Fundus photo:
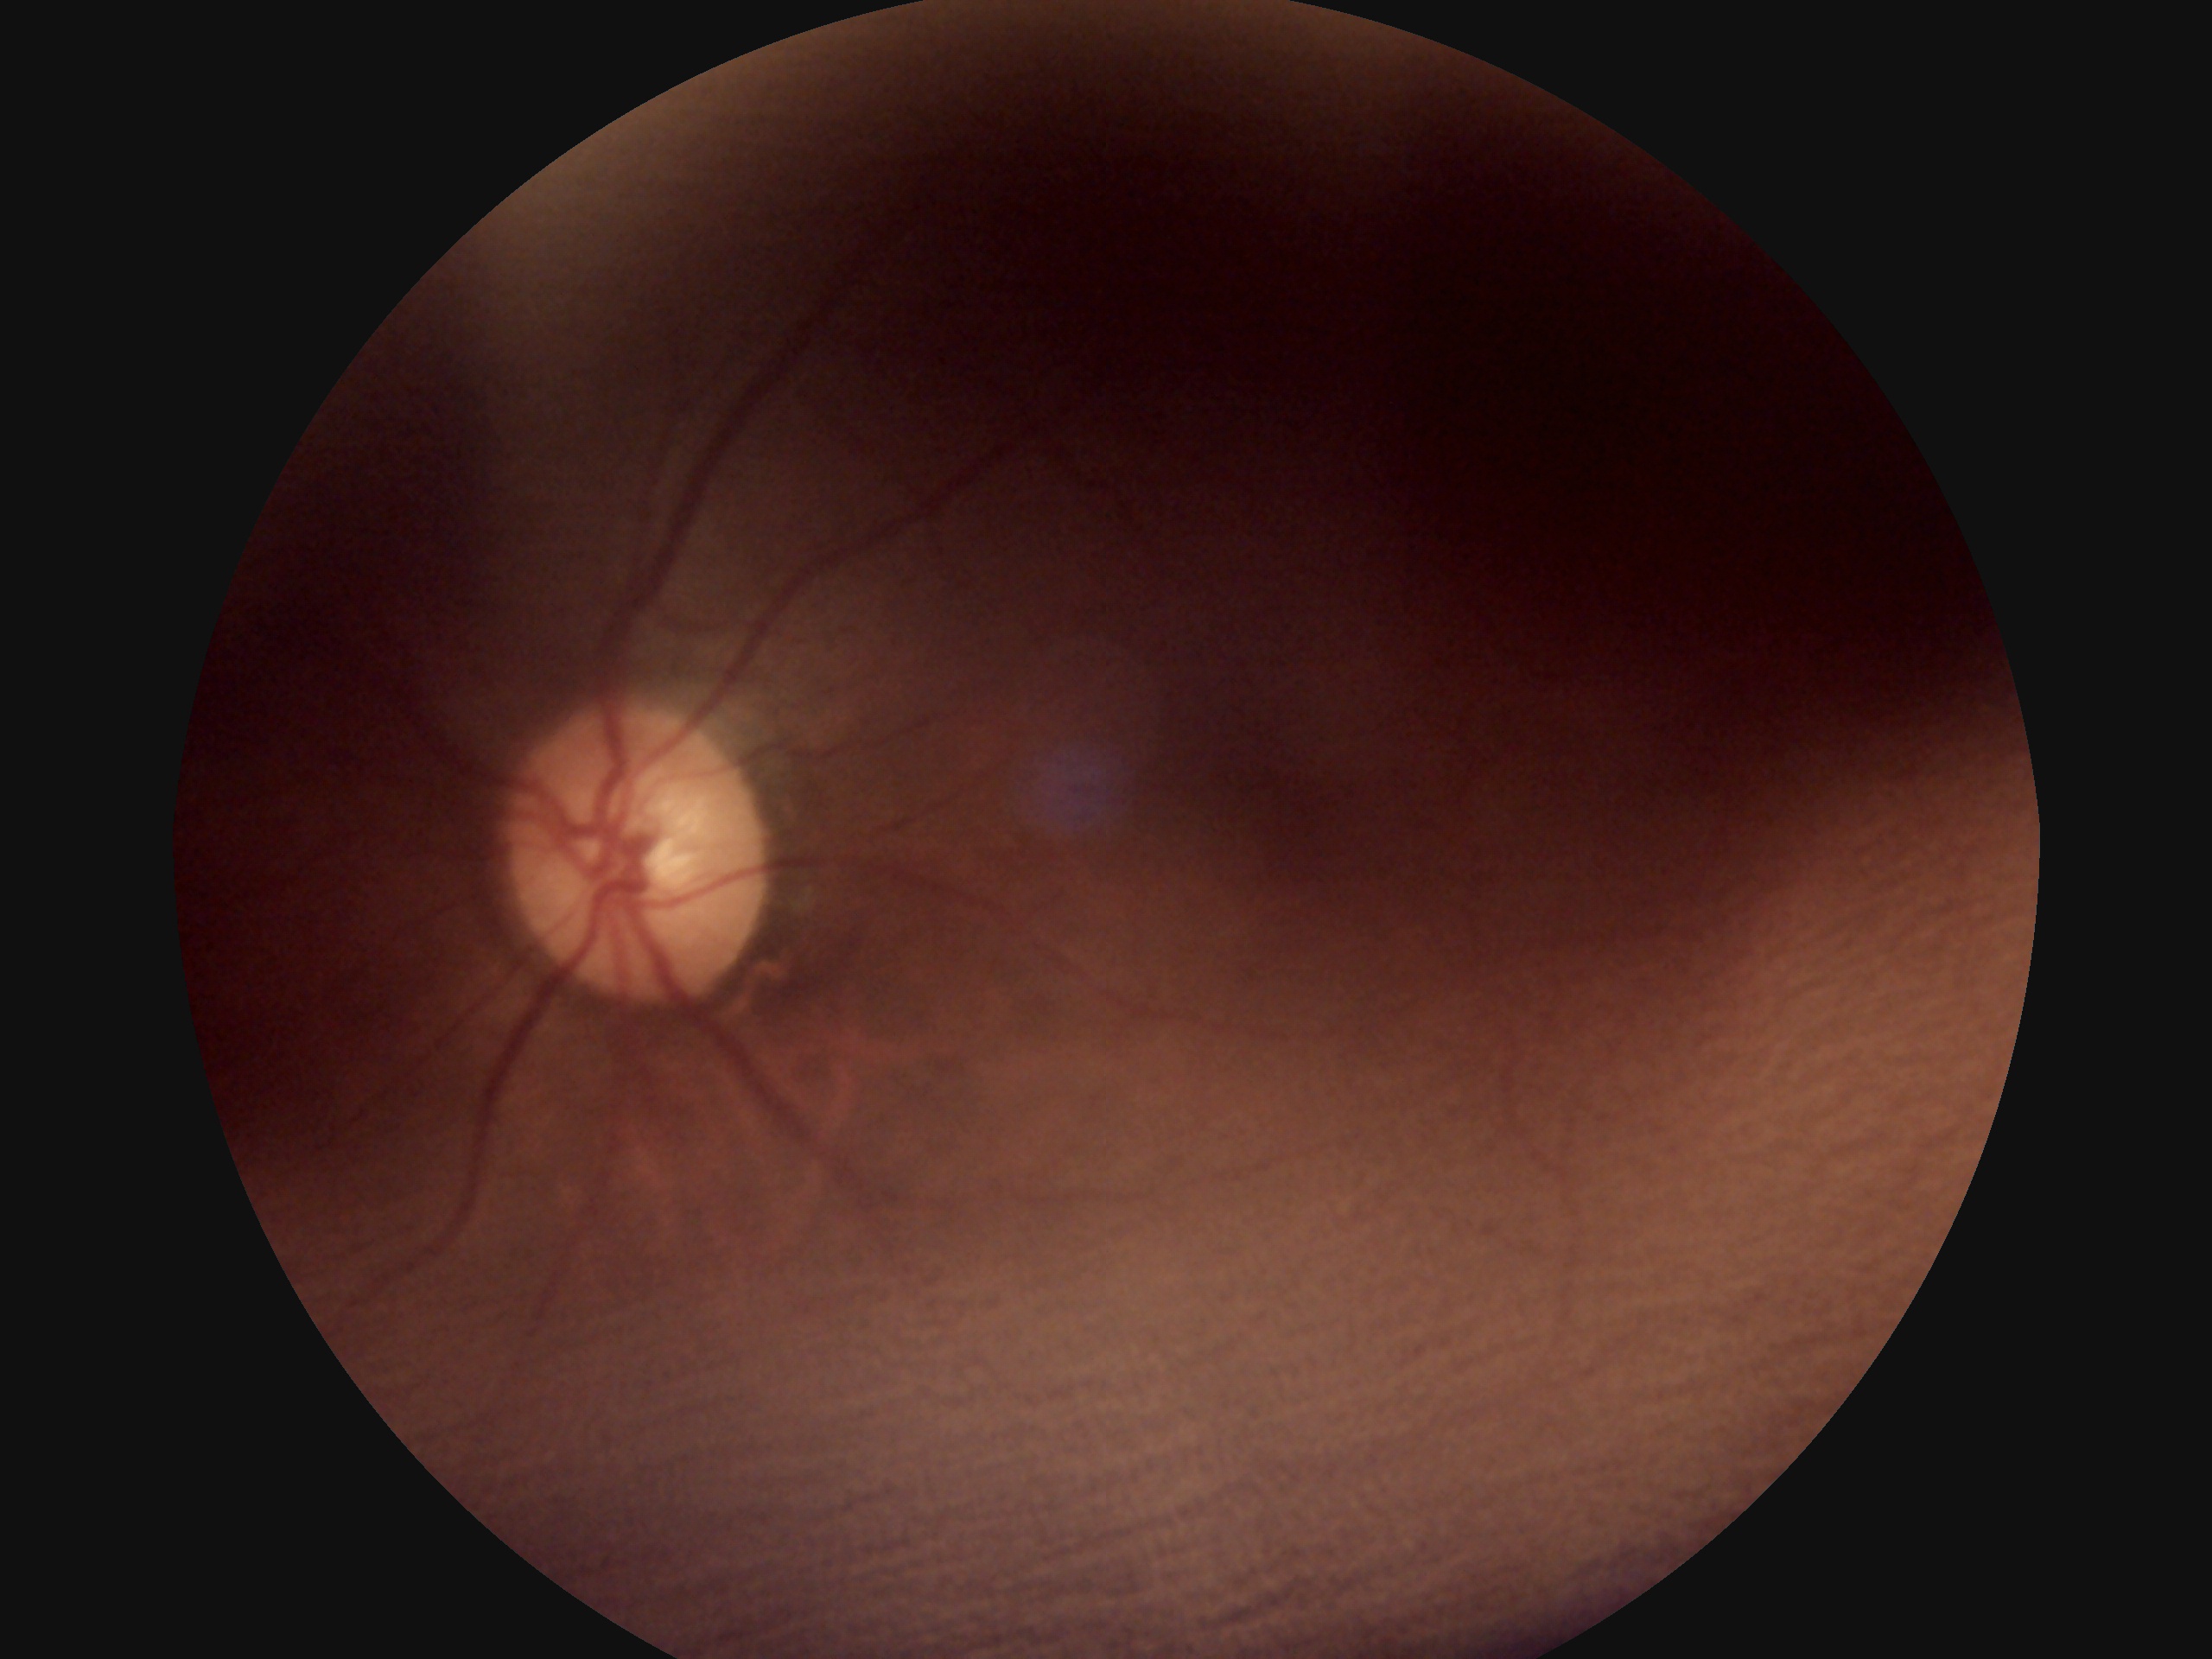

Image quality is insufficient for diabetic retinopathy assessment.
Diabetic retinopathy: ungradable due to poor image quality.